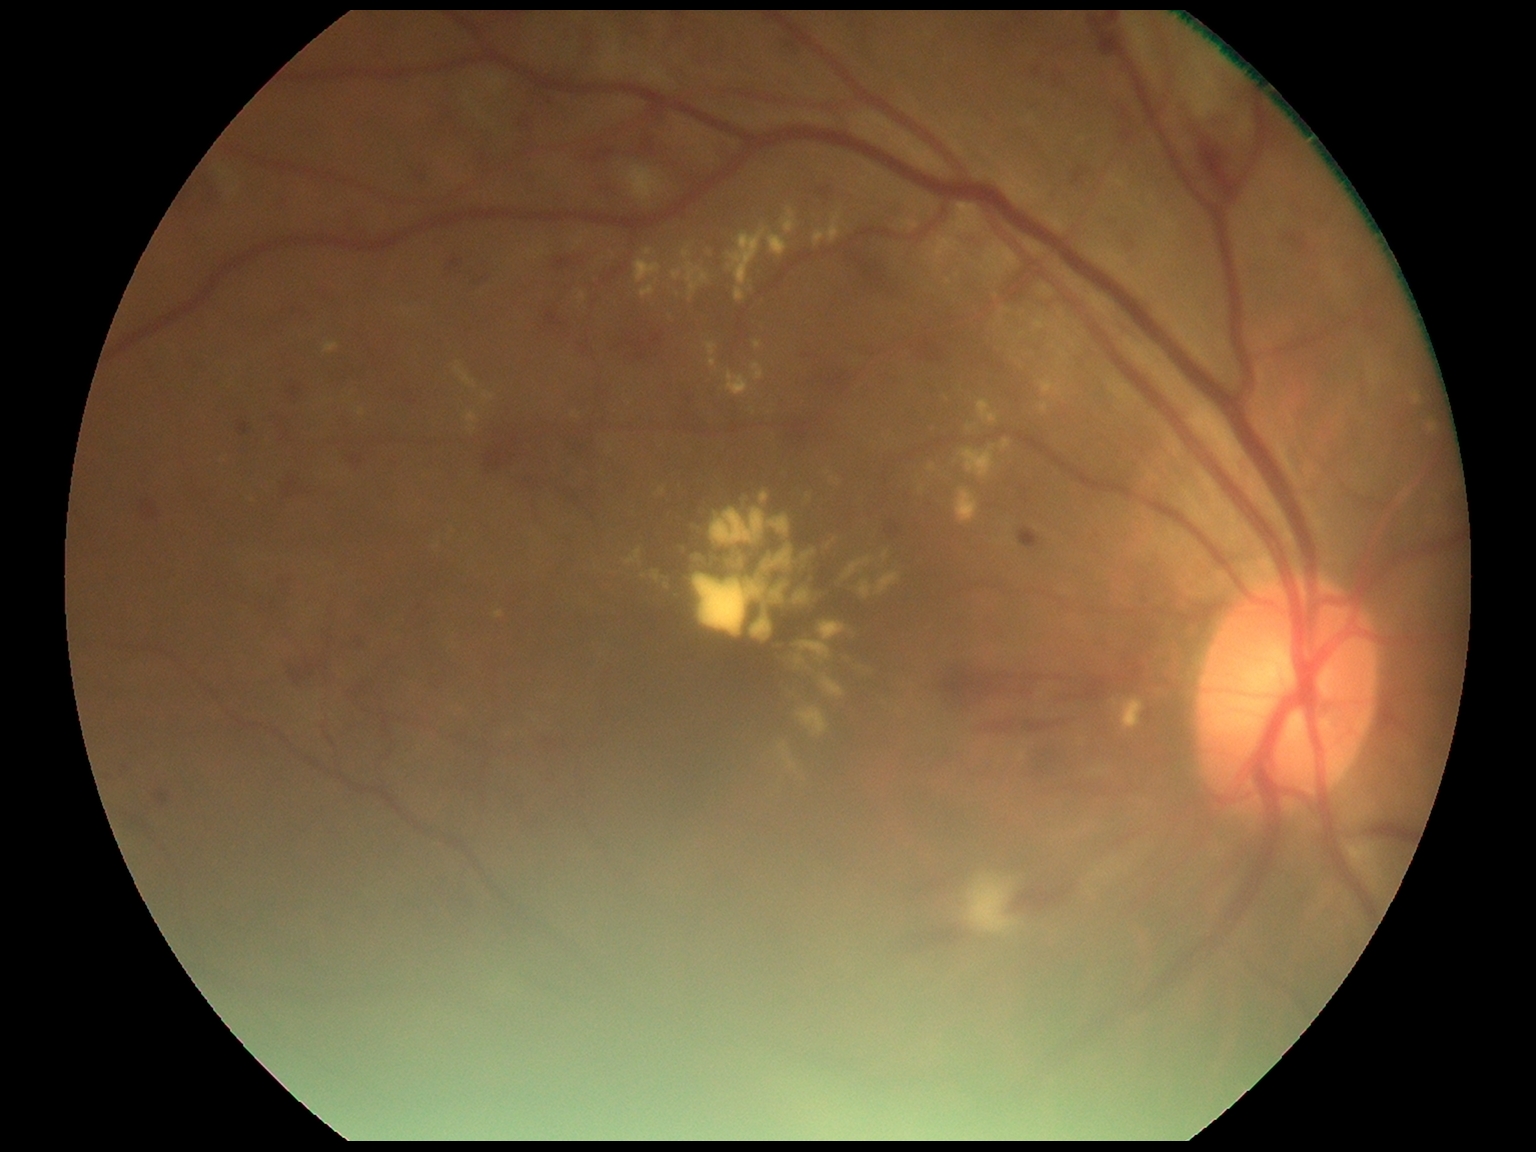 Diabetic retinopathy: moderate non-proliferative diabetic retinopathy (grade 2).
DR class: non-proliferative diabetic retinopathy.